Without pupil dilation.
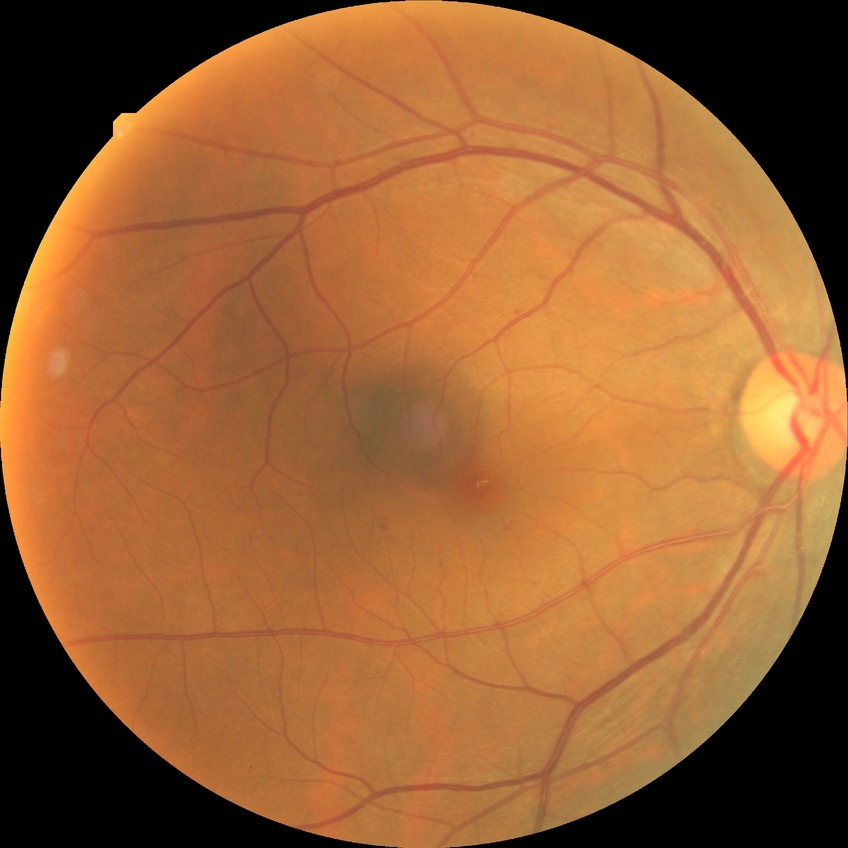

DR@SDR.